Wide-field contact fundus photograph of an infant: 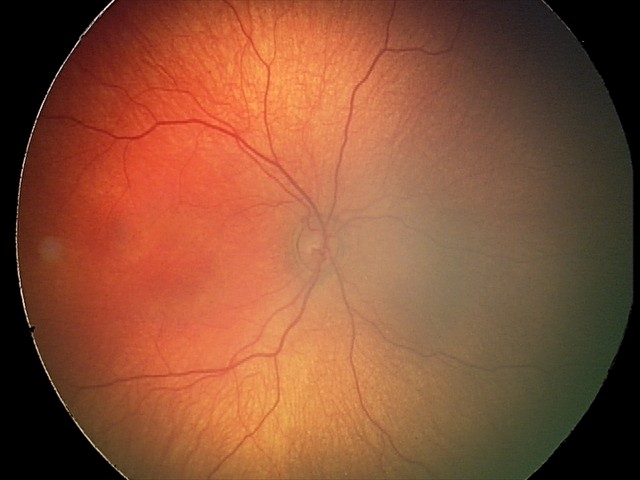
Physiological retinal appearance for postconceptual age.